NIDEK AFC-230; posterior pole photograph; image size 848x848; nonmydriatic fundus photograph; 45 degree fundus photograph:
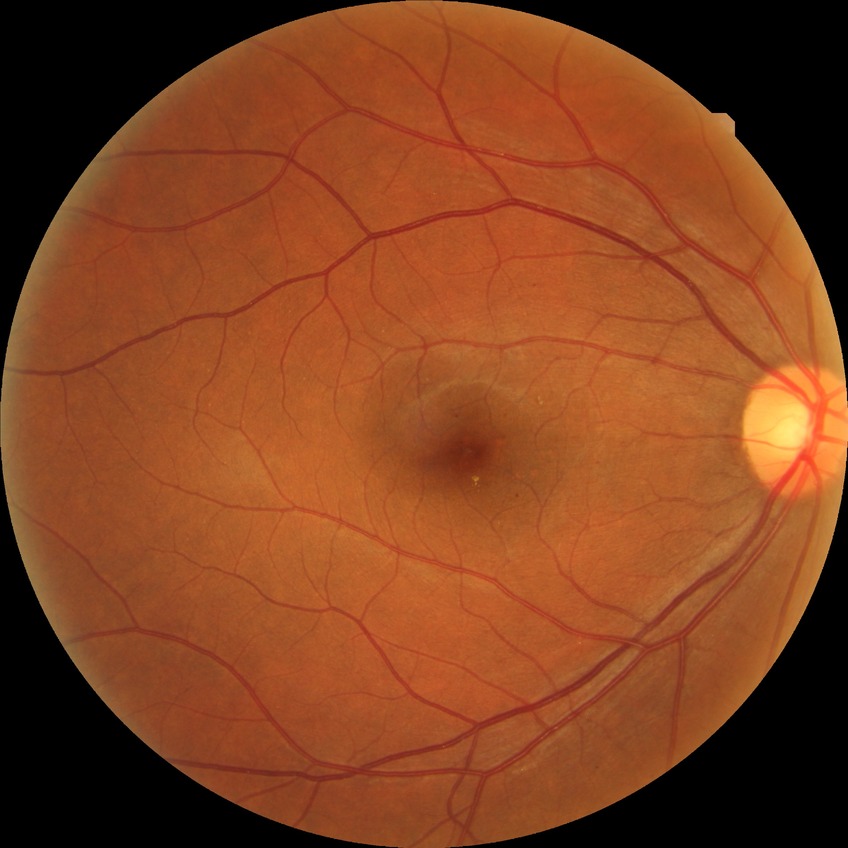

diabetic retinopathy severity@simple diabetic retinopathy.